640 x 480 pixels · wide-field fundus image from infant ROP screening.
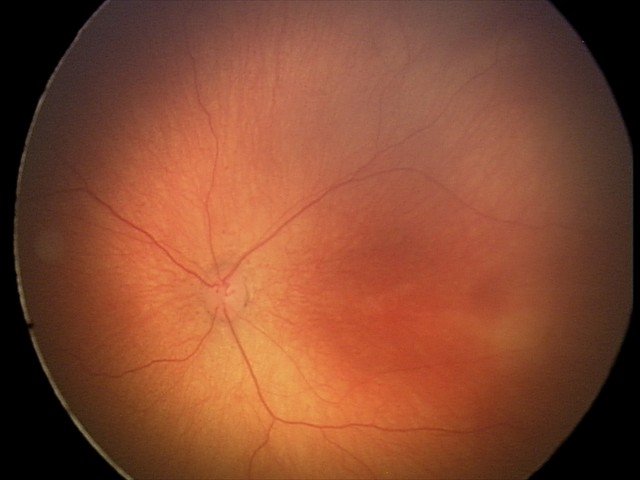
Q: What was the screening finding?
A: ROP stage 1